Image size 640x480 · wide-field fundus photograph of an infant — 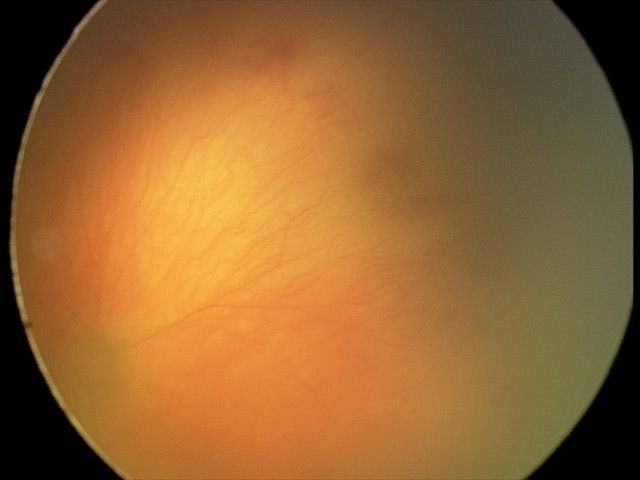
Plus disease was diagnosed. Screening examination consistent with aggressive retinopathy of prematurity.